Color fundus photograph. 2048 by 1536 pixels — 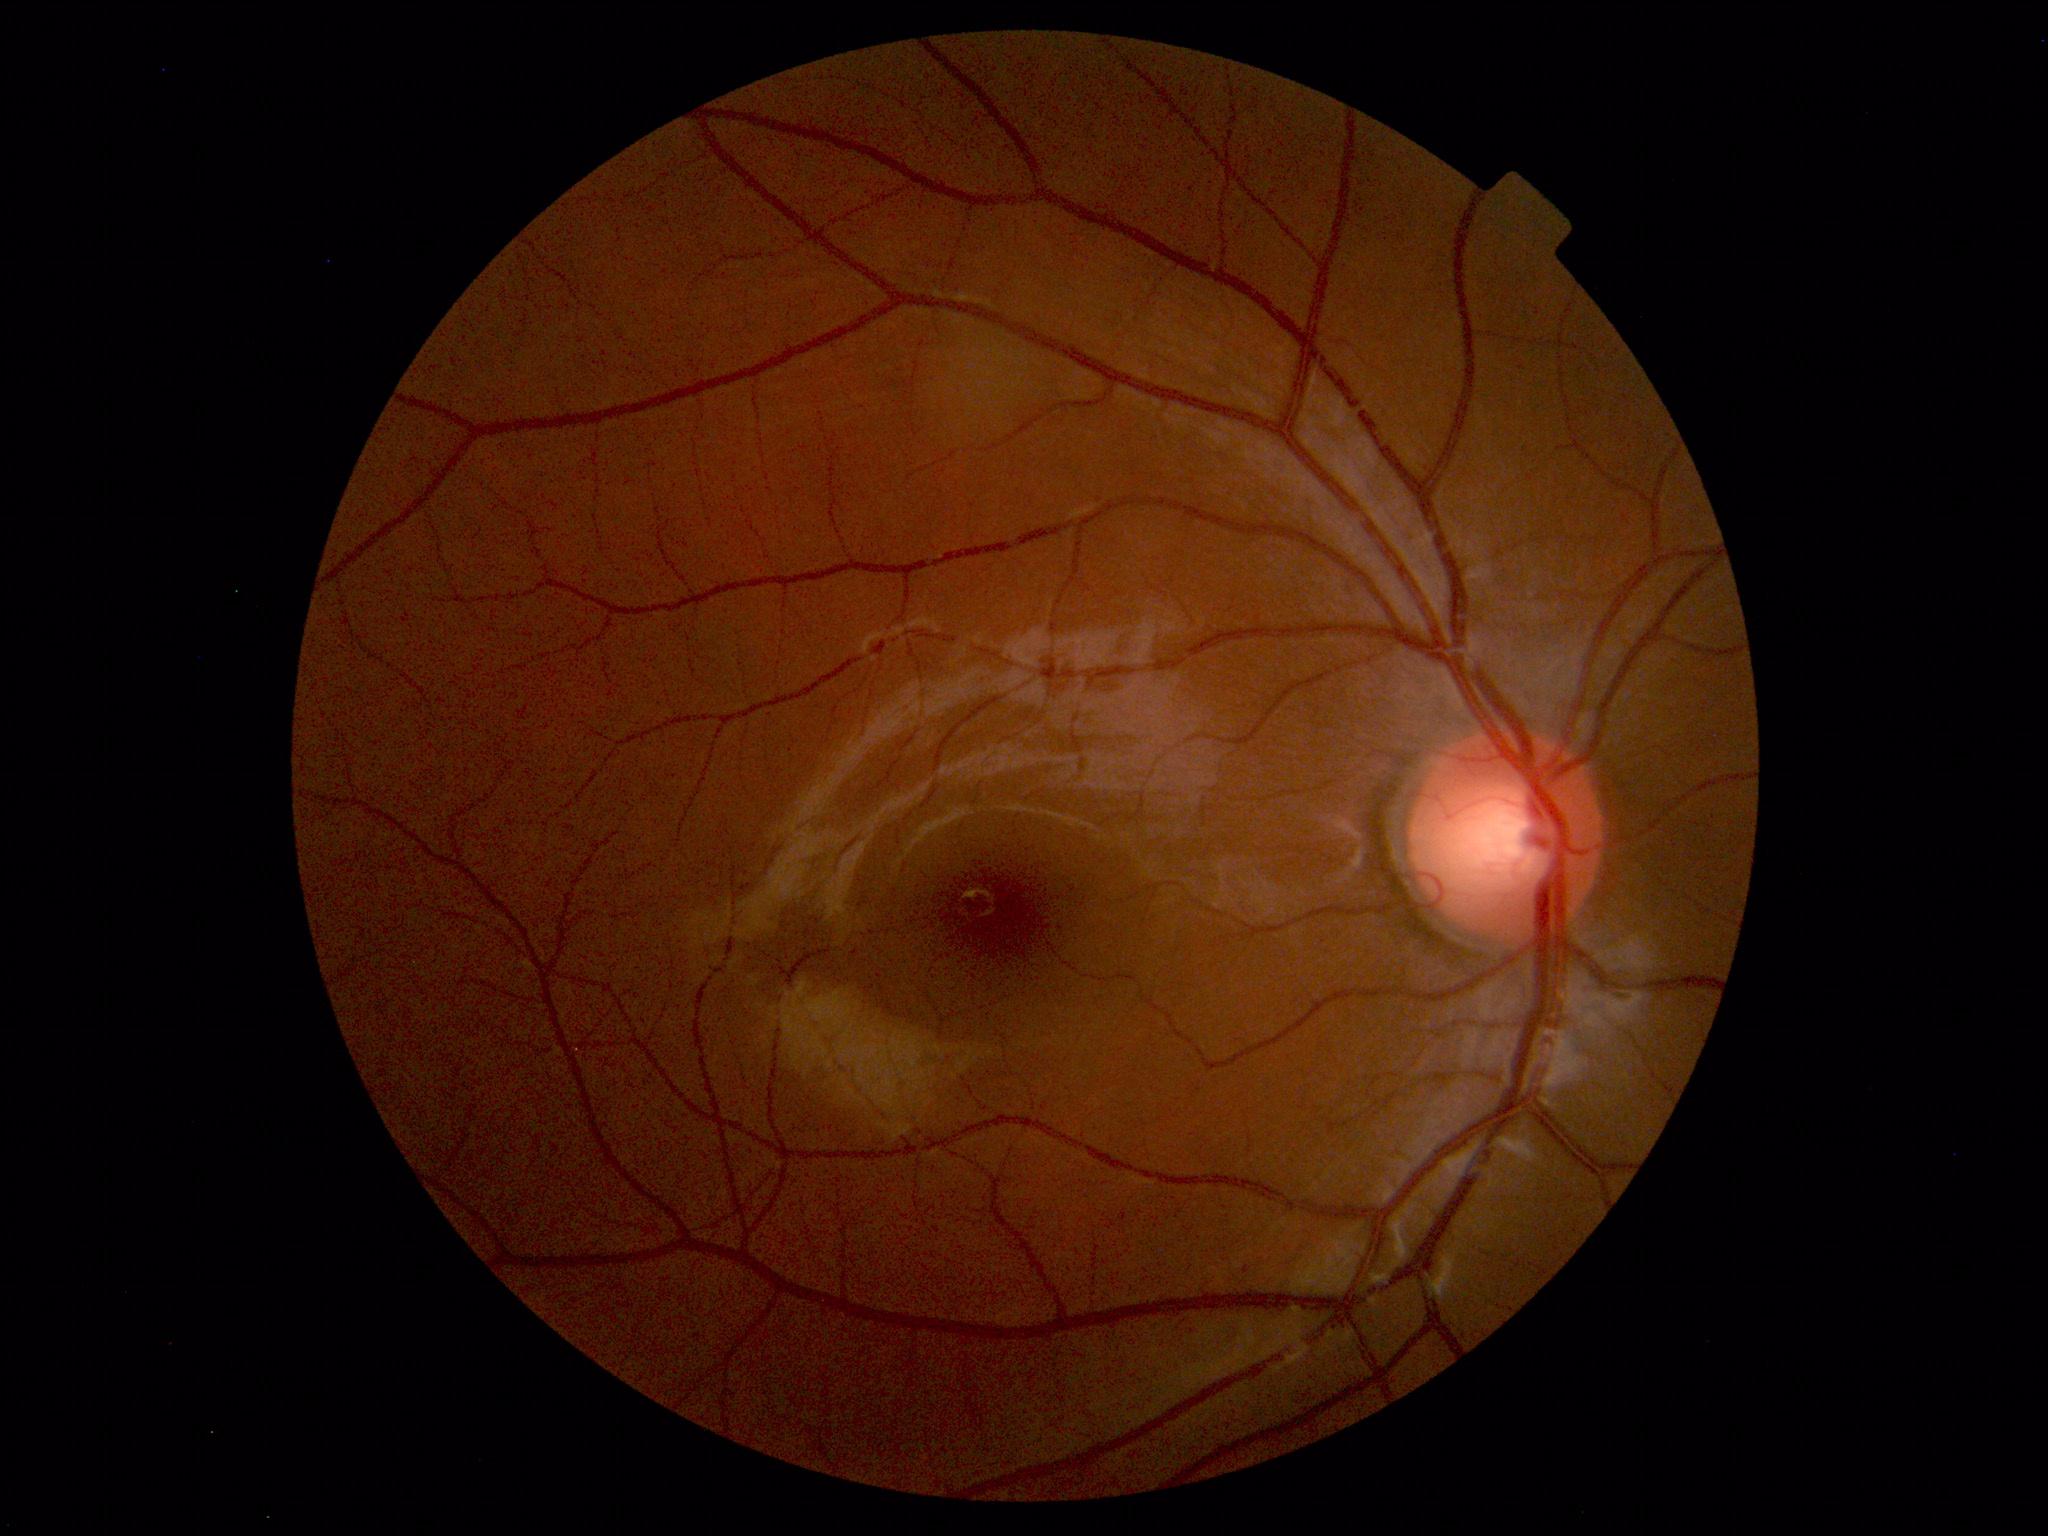 Normal fundus appearance.